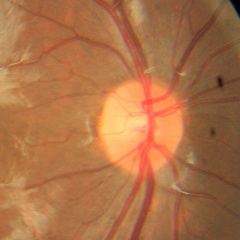

Showing no glaucomatous changes.